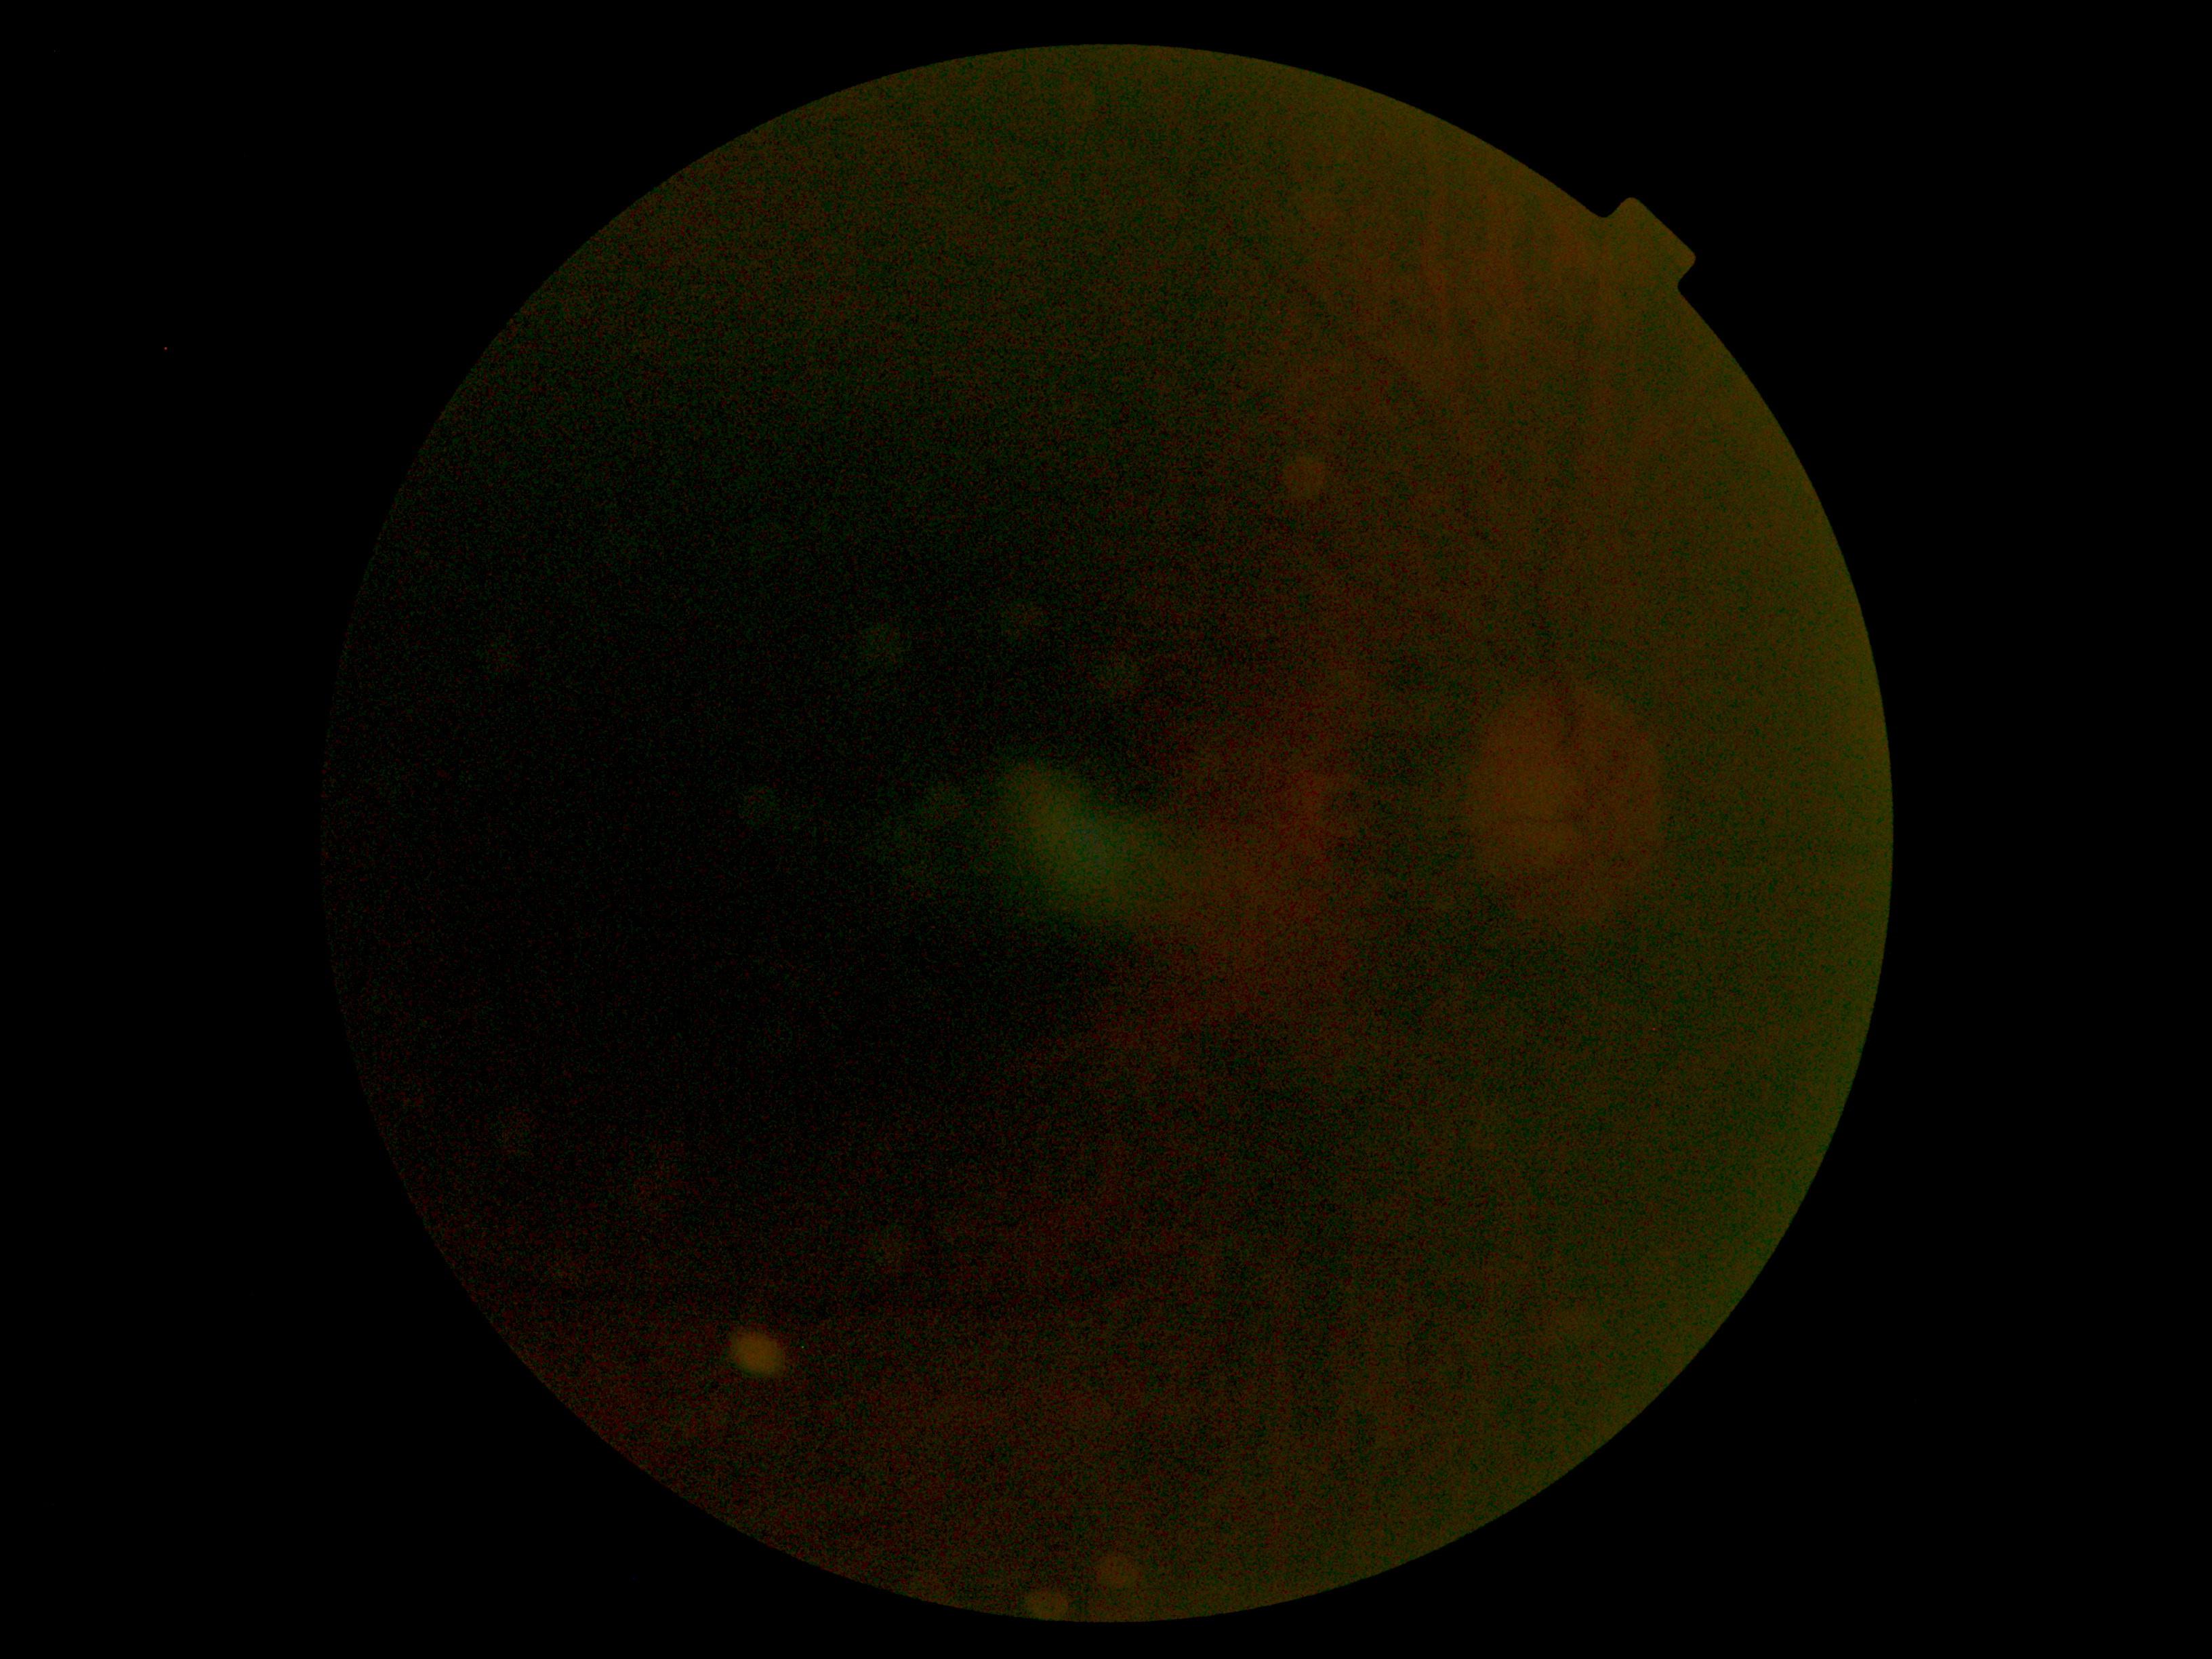 The image cannot be graded for diabetic retinopathy. DR grade is ungradable due to poor image quality.